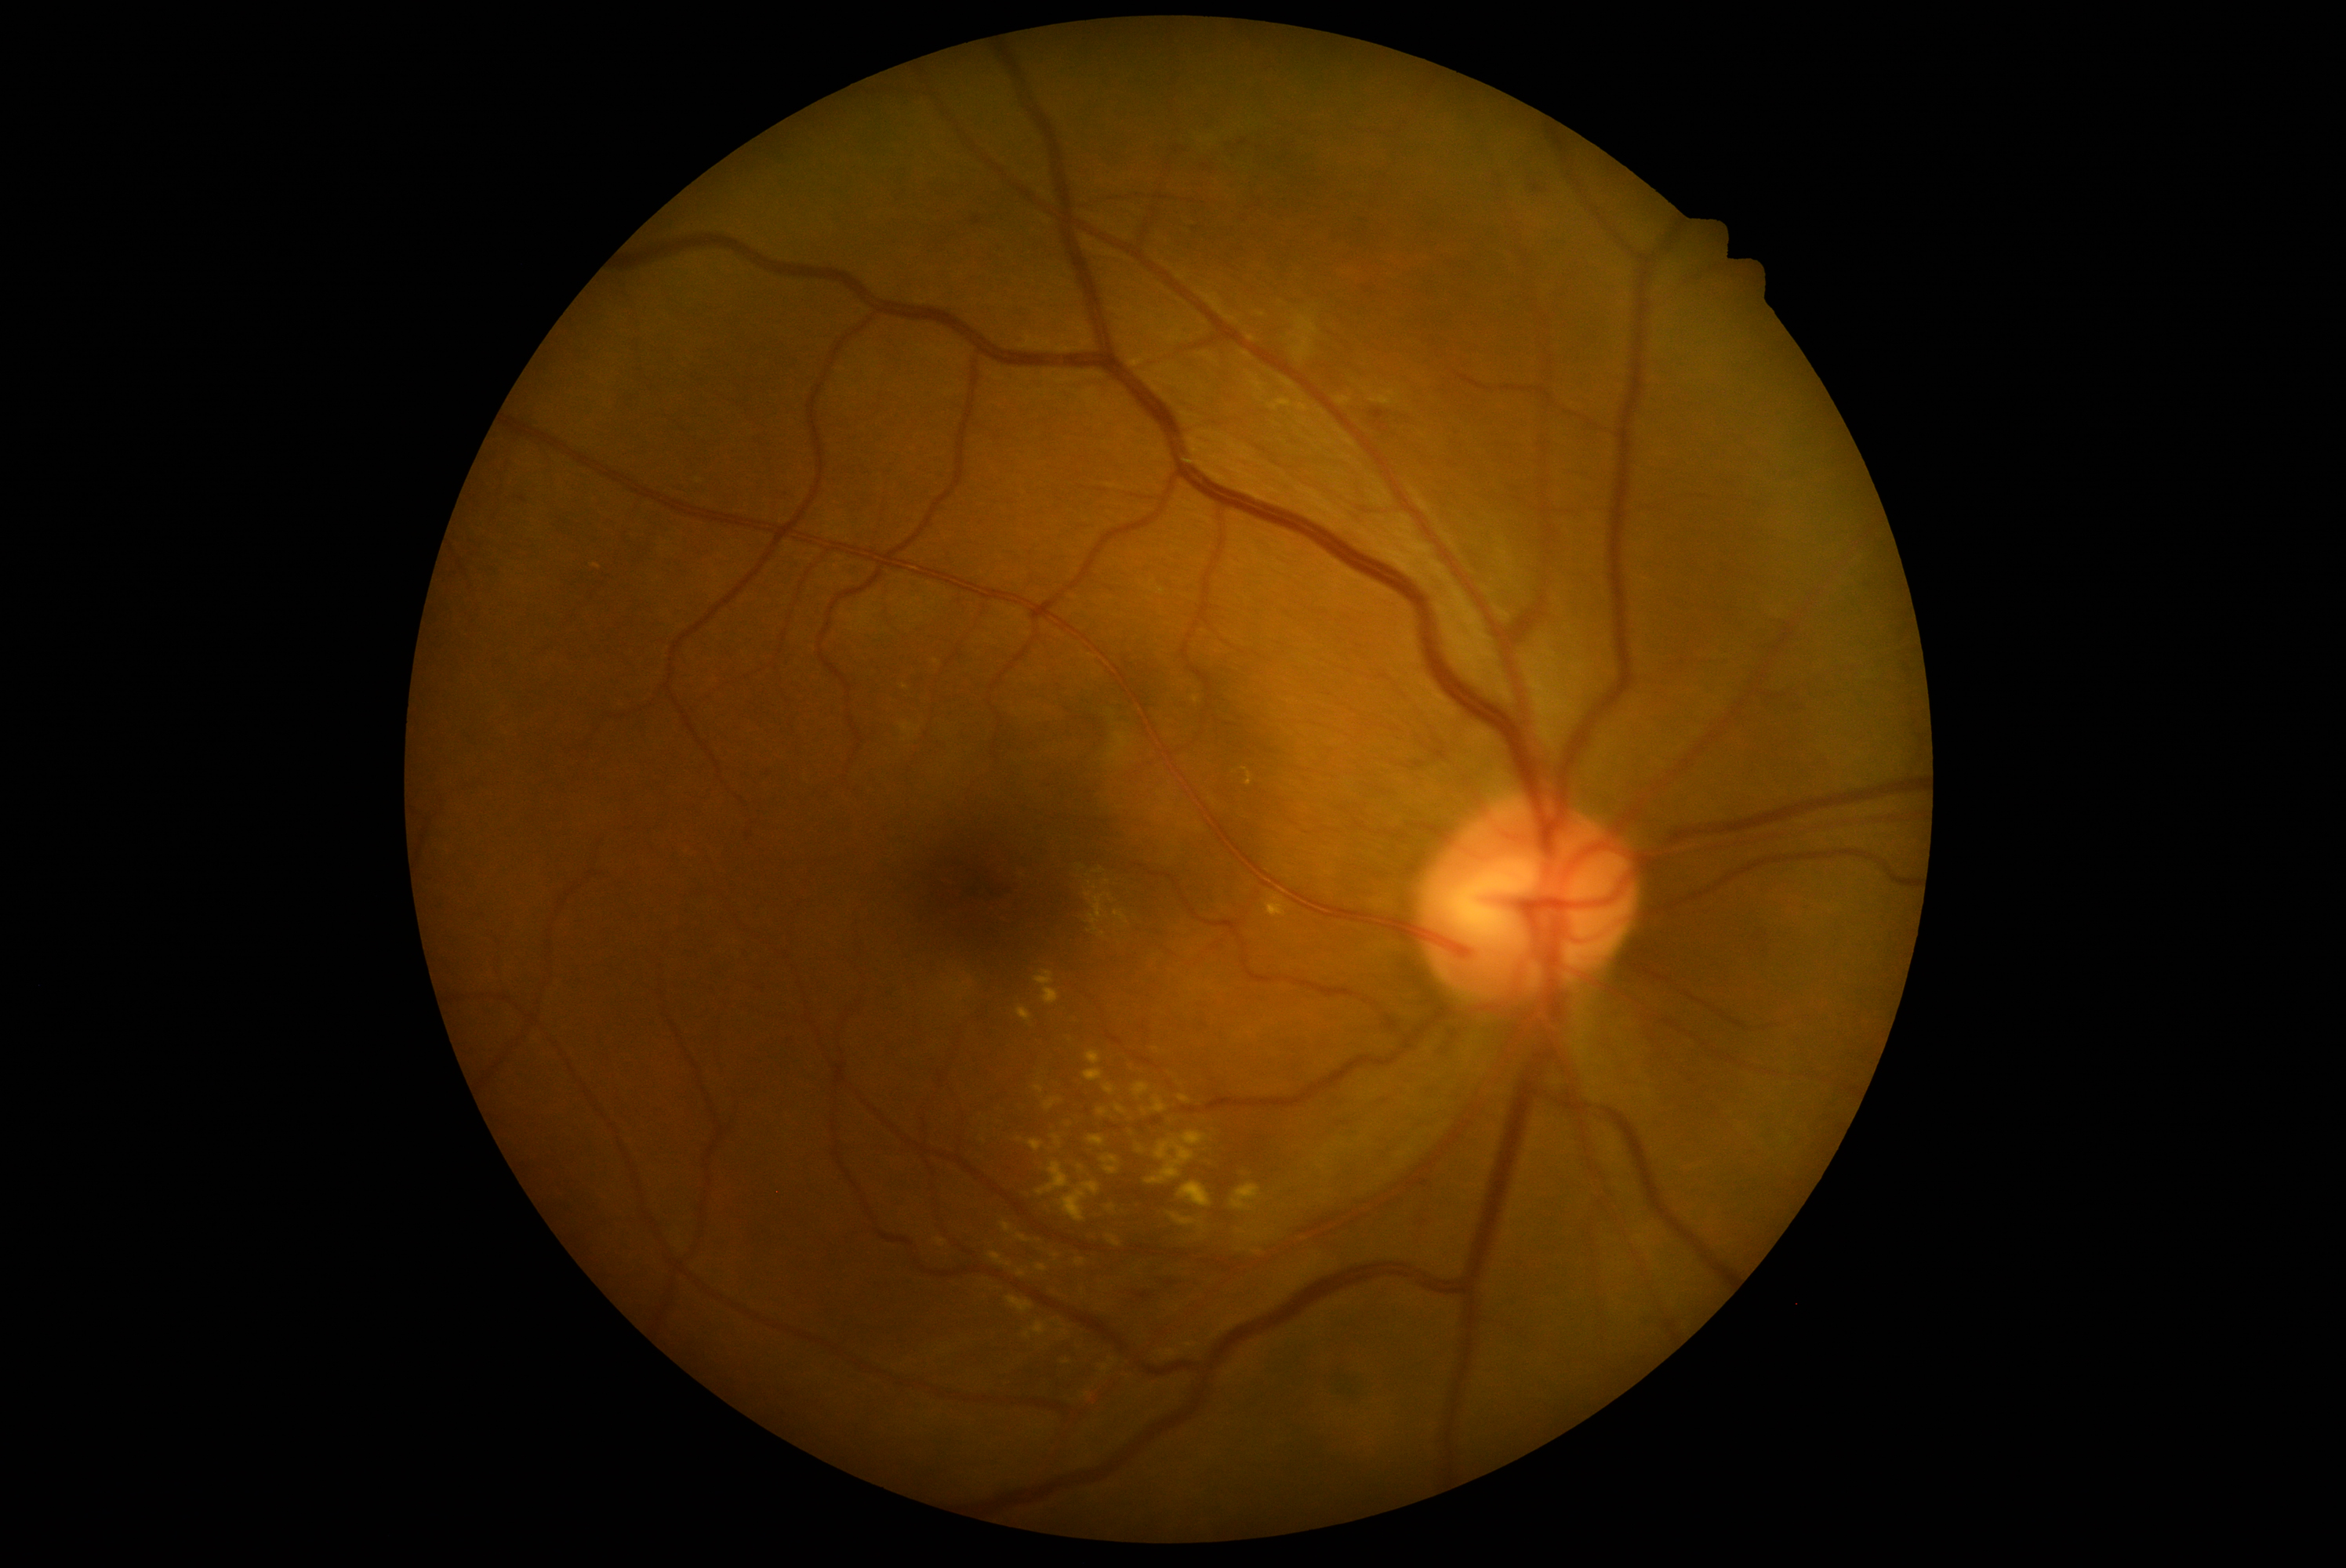

Diabetic retinopathy (DR) is 2/4. Hard exudates (EXs) include lesions at {"x1": 1108, "y1": 1236, "x2": 1122, "y2": 1247}, {"x1": 1114, "y1": 910, "x2": 1128, "y2": 924}, {"x1": 937, "y1": 1240, "x2": 948, "y2": 1246}, {"x1": 1269, "y1": 909, "x2": 1282, "y2": 916}, {"x1": 1178, "y1": 1095, "x2": 1191, "y2": 1105}, {"x1": 1086, "y1": 891, "x2": 1113, "y2": 926}, {"x1": 1006, "y1": 1298, "x2": 1033, "y2": 1313}, {"x1": 1017, "y1": 1271, "x2": 1026, "y2": 1277}, {"x1": 1197, "y1": 1156, "x2": 1218, "y2": 1167}, {"x1": 1152, "y1": 1097, "x2": 1168, "y2": 1114}. EXs (small, approximate centers) near x=1189 y=1345, x=1105 y=1368, x=1144 y=1113, x=1020 y=1140, x=1028 y=1336, x=1056 y=1257.